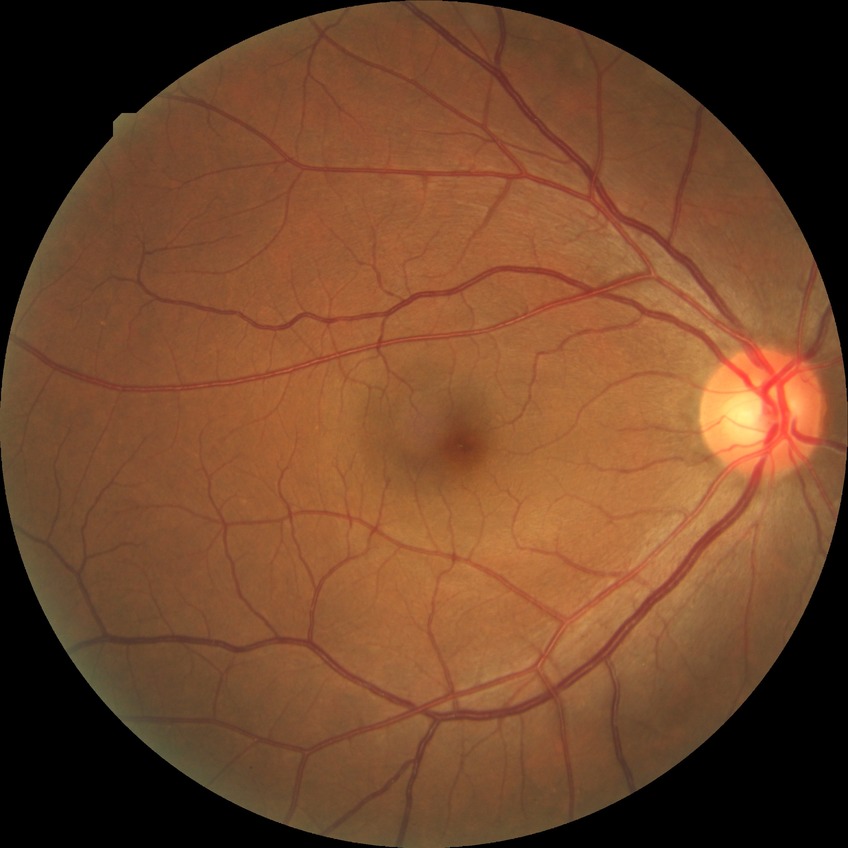 diabetic retinopathy (DR): NDR (no diabetic retinopathy).